Retinal fundus photograph. 45-degree field of view: 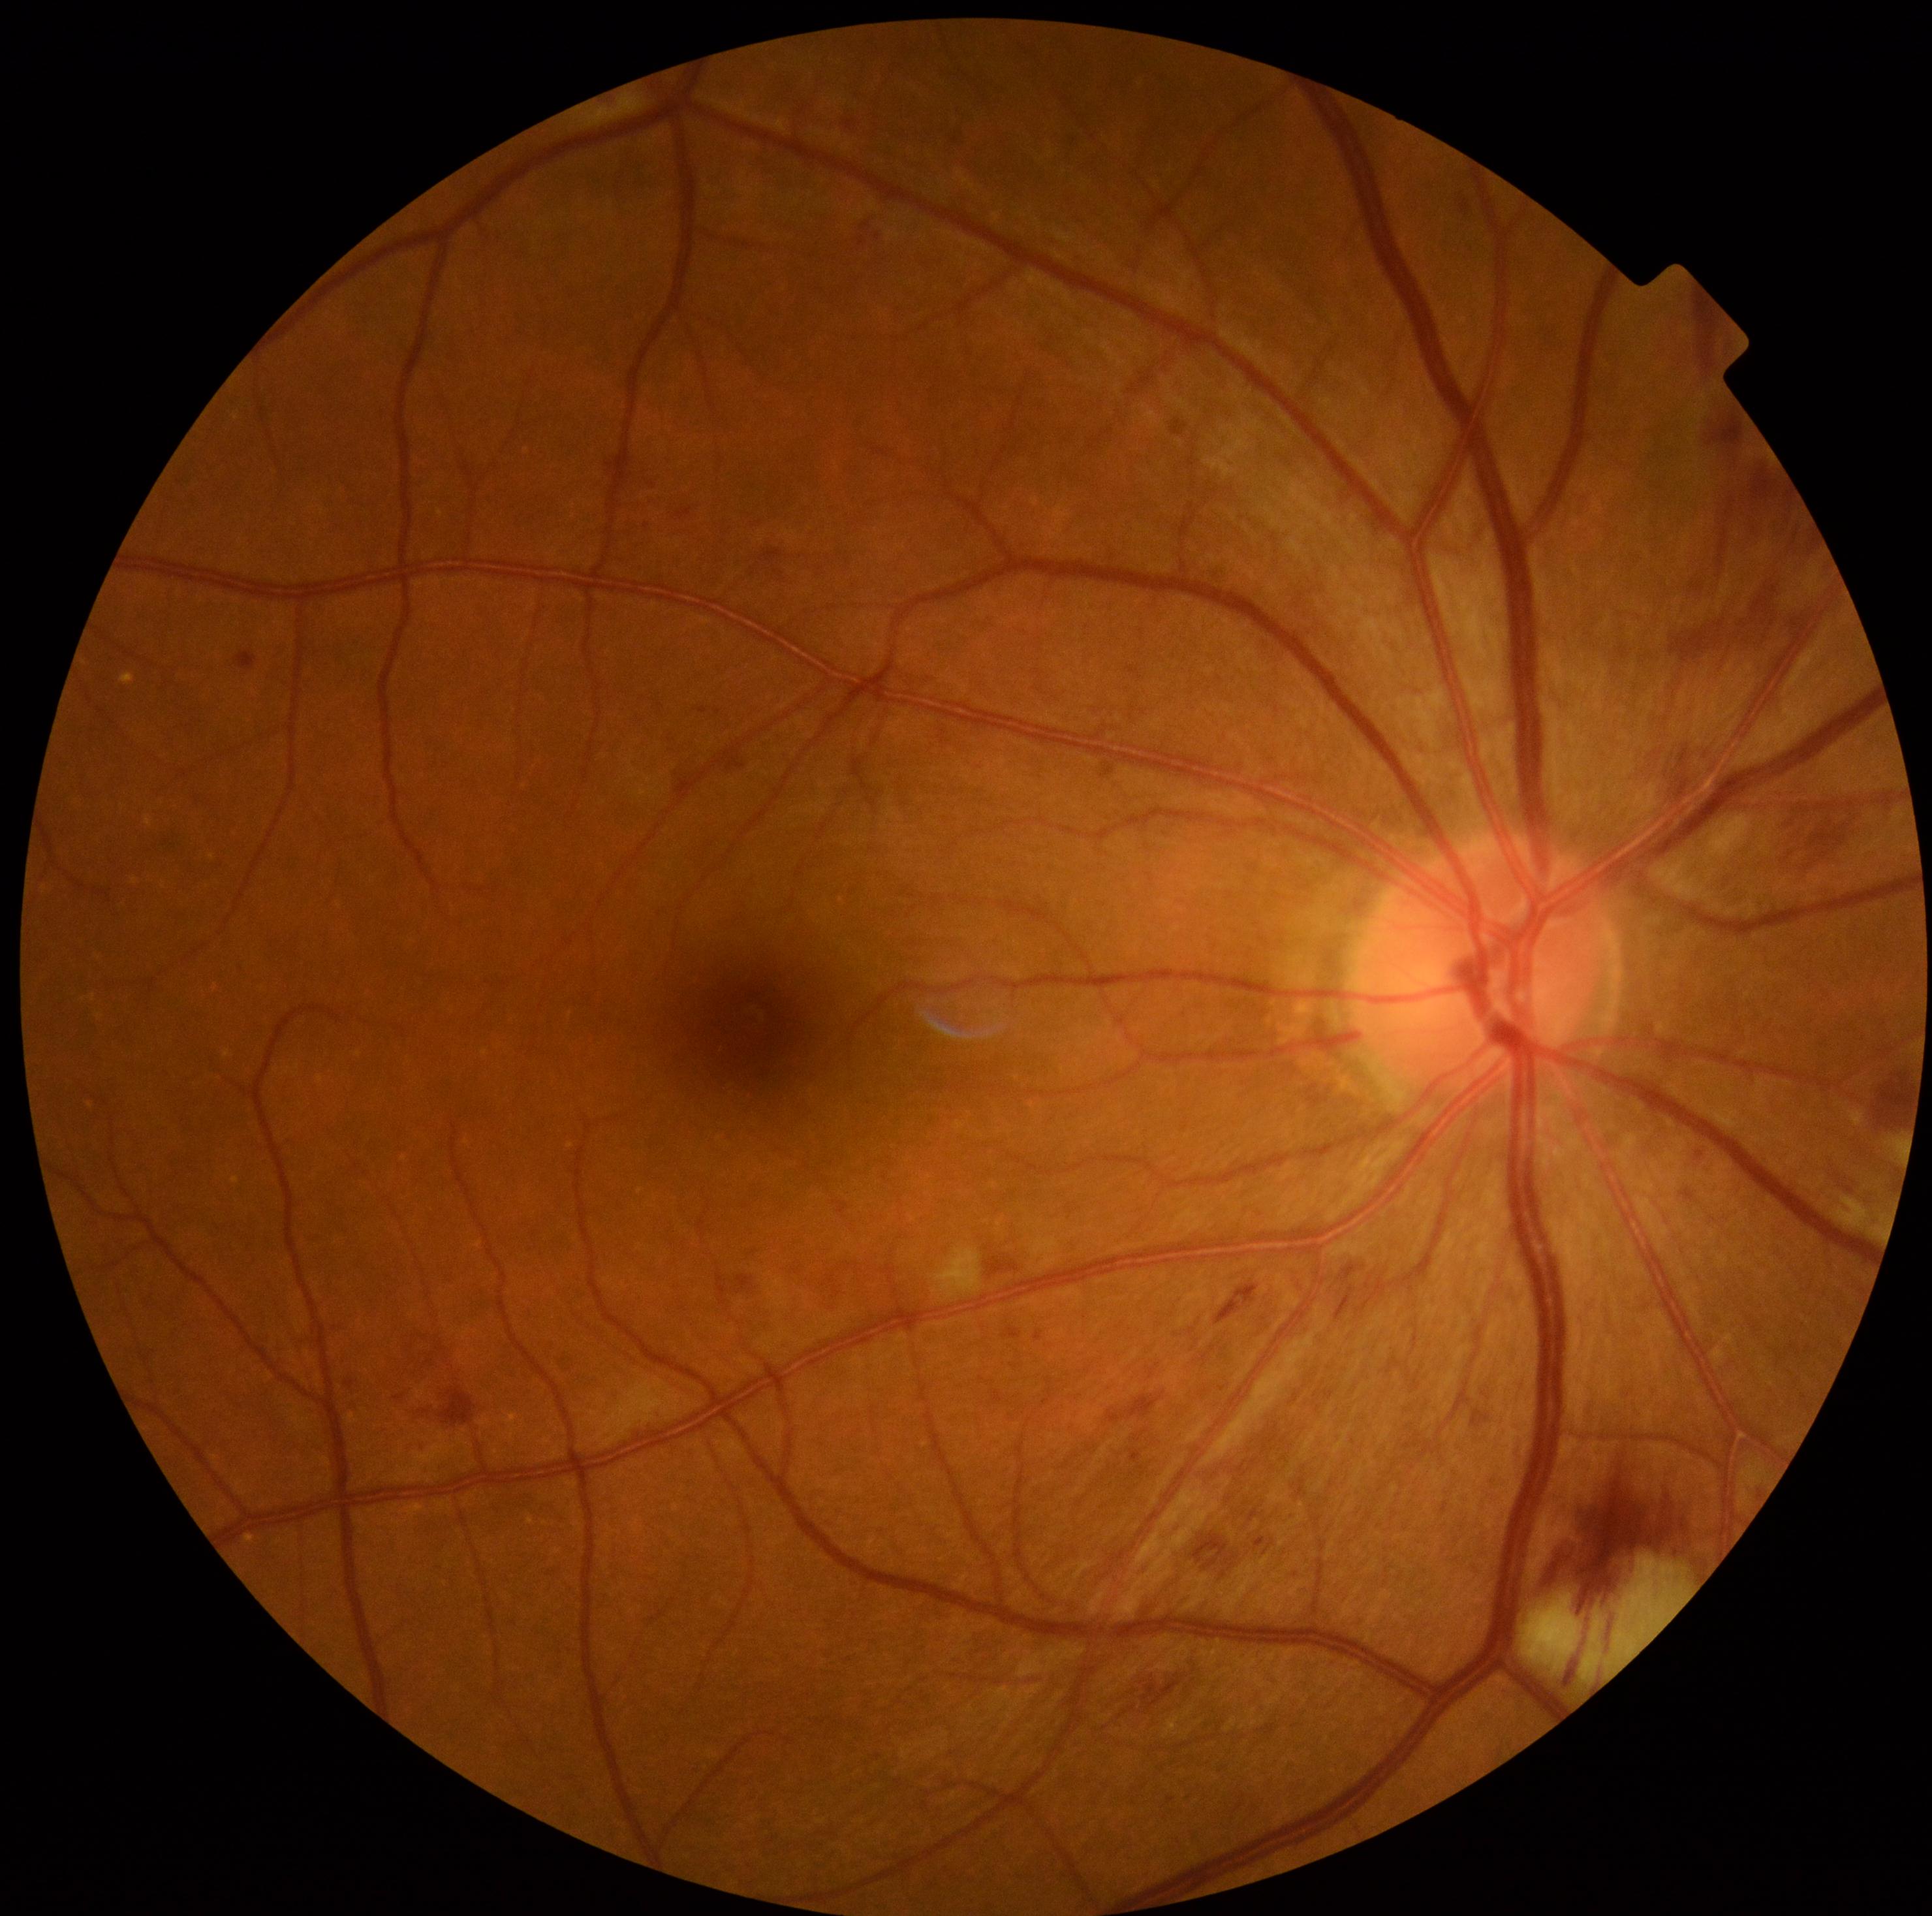
Diabetic retinopathy severity is 2.